Non-mydriatic fundus camera — 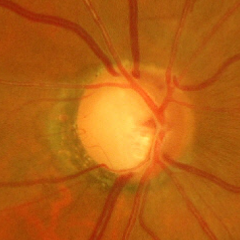 Advanced-stage glaucoma.